Wide-field fundus image from infant ROP screening · 640x480px
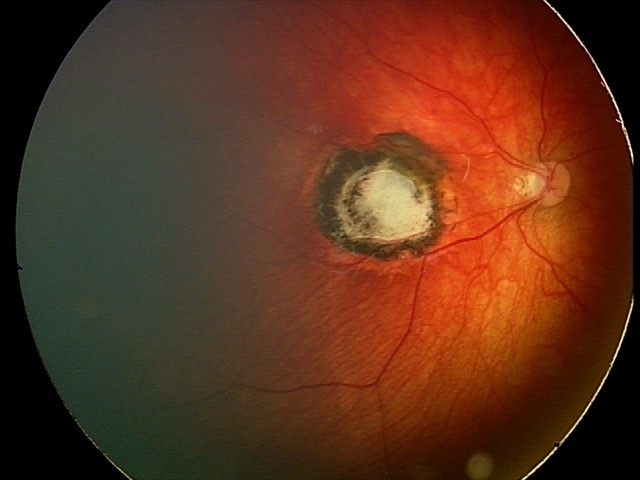

From an examination with diagnosis of toxoplasmosis chorioretinitis.